CFP
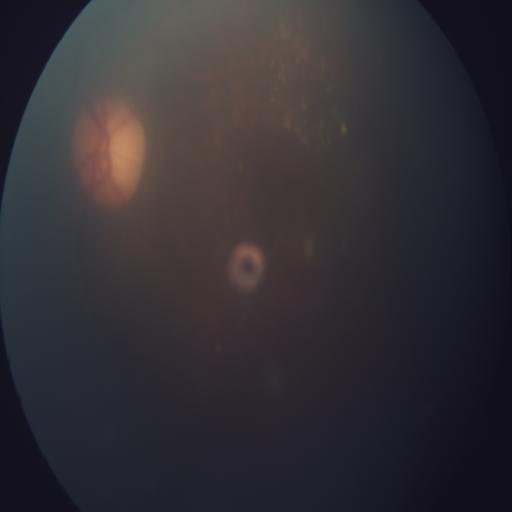 Demonstrates EDN (exudation).